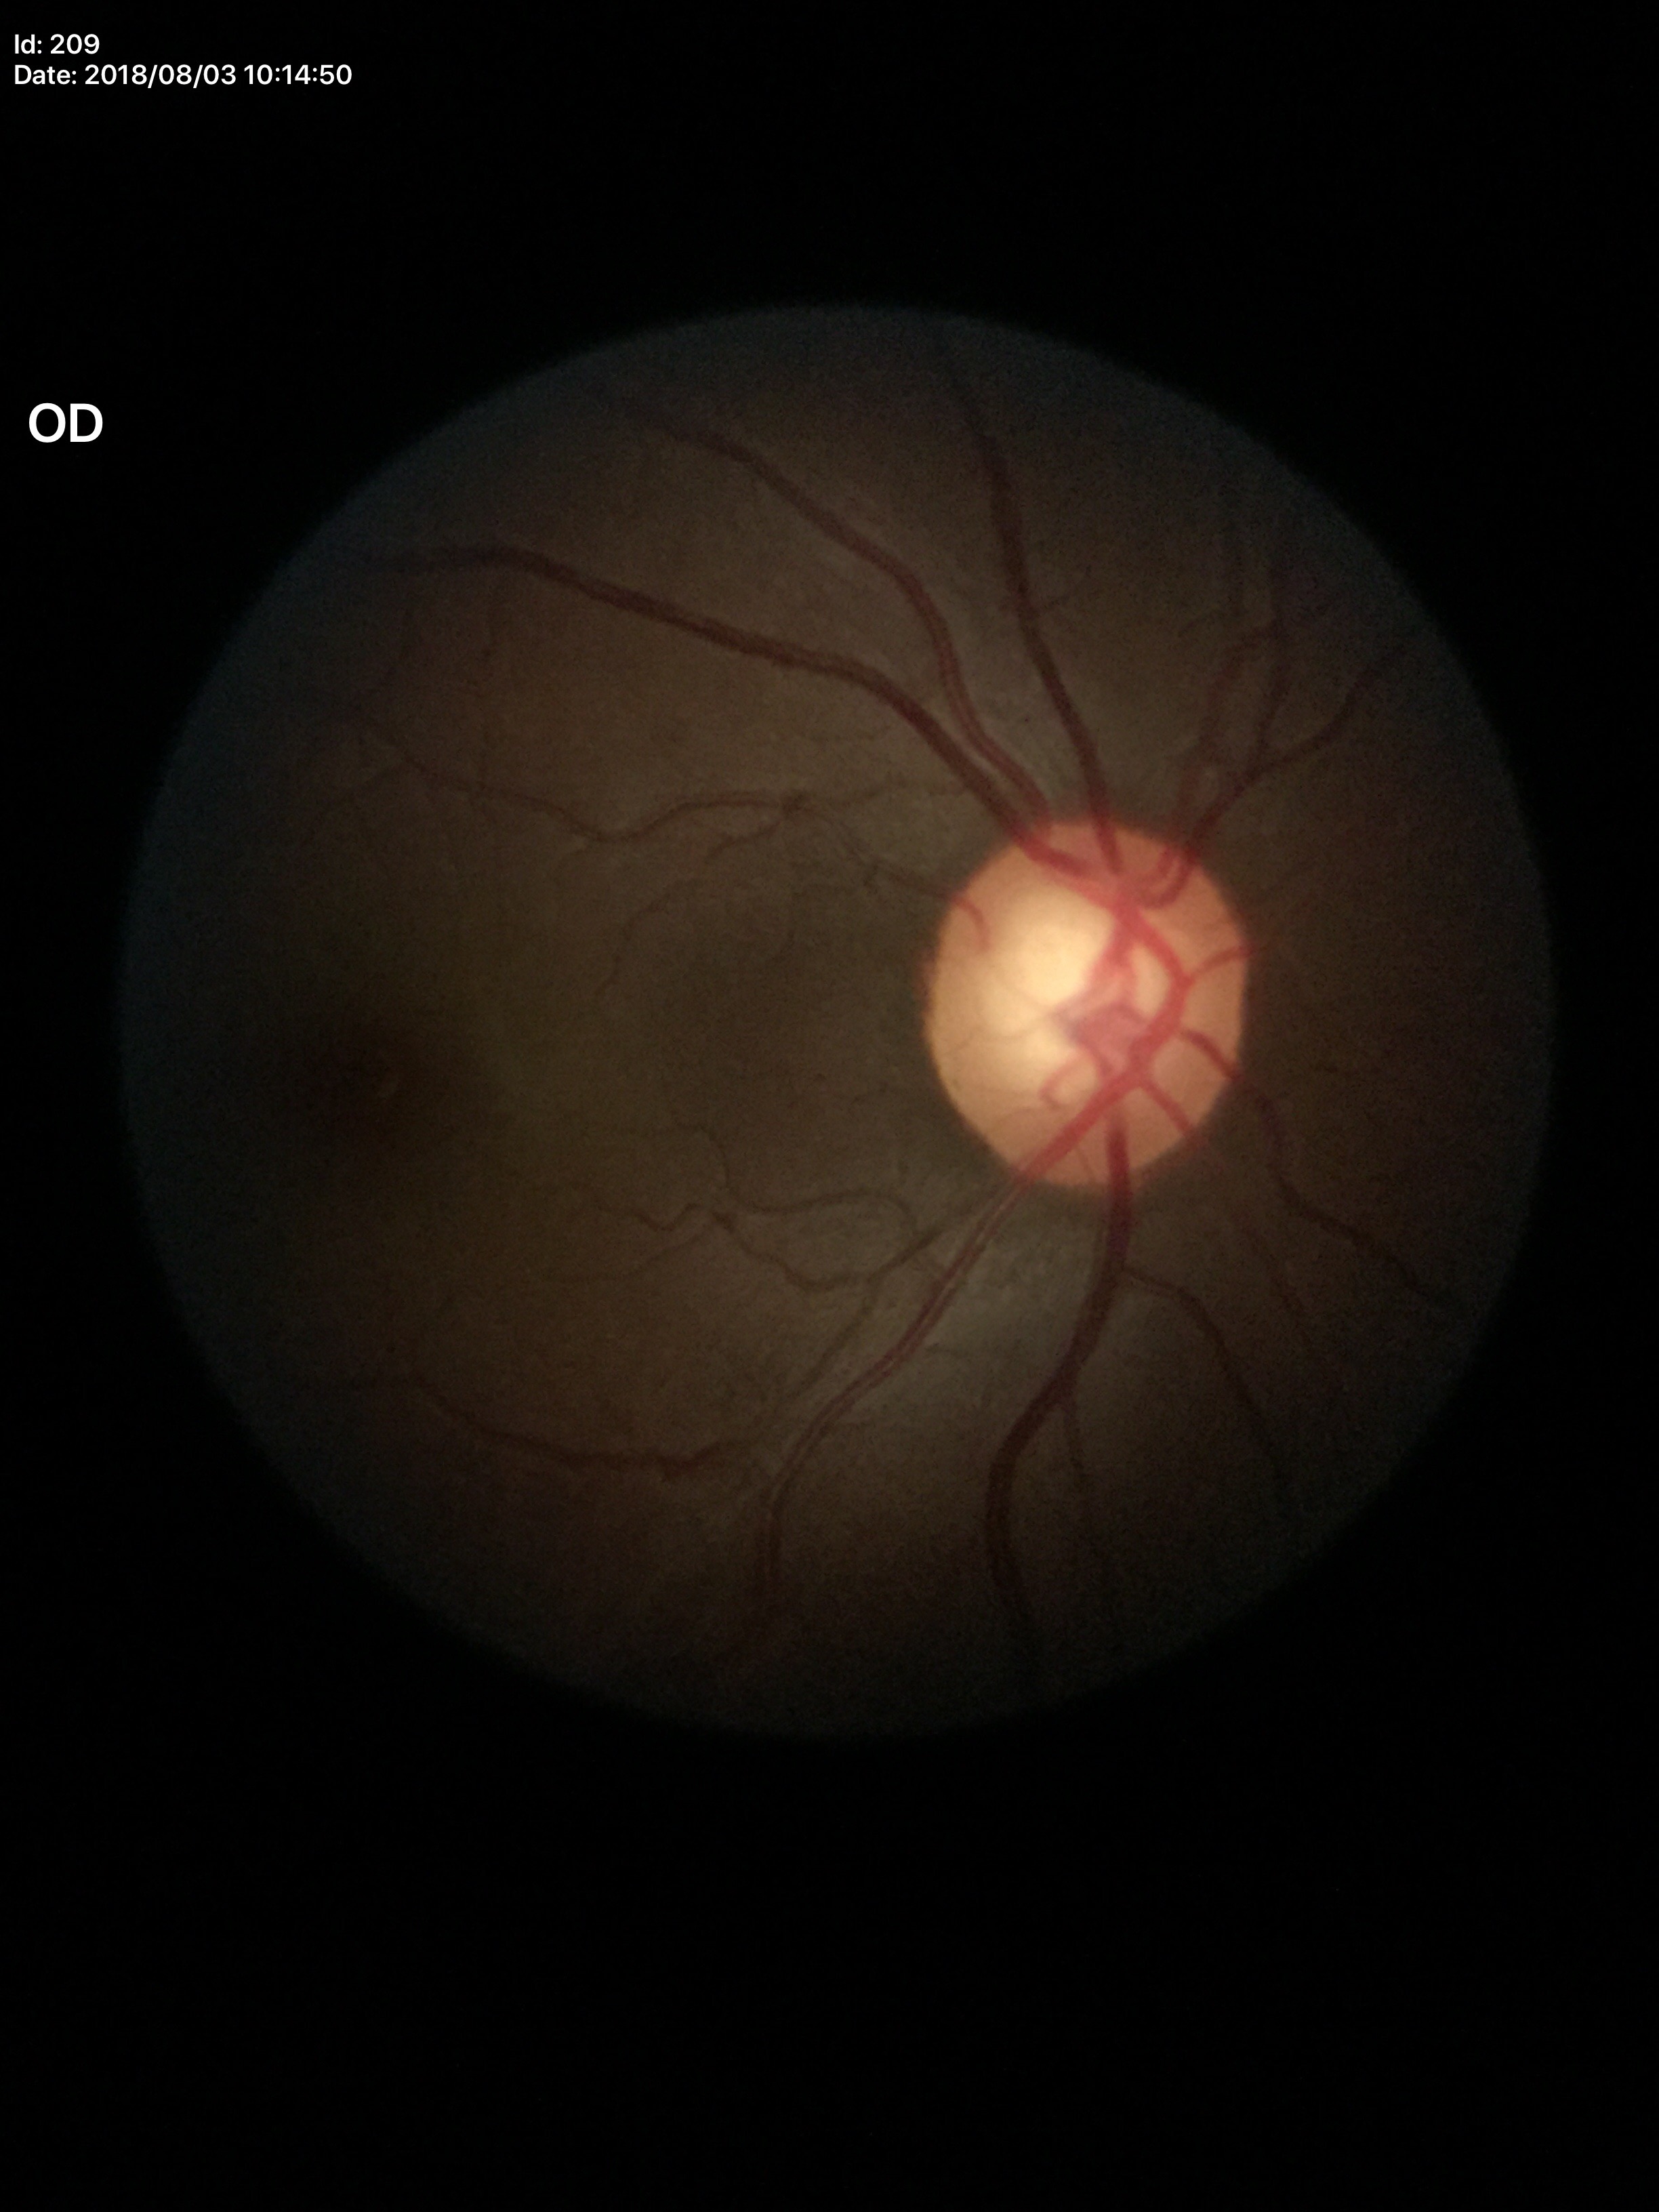

Q: What is the glaucoma assessment?
A: suspicious
Q: What is the HCDR?
A: 0.63
Q: What is the vertical cup-to-disc ratio?
A: 0.62